RetCam wide-field infant fundus image · acquired on the Clarity RetCam 3 · 640x480 — 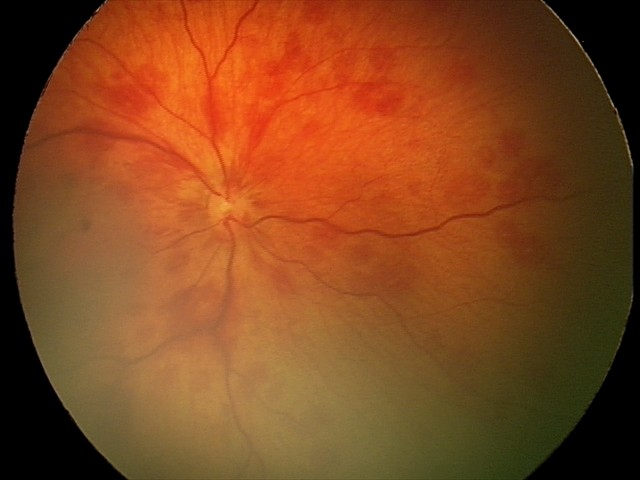 From an examination with diagnosis of retinal hemorrhages.